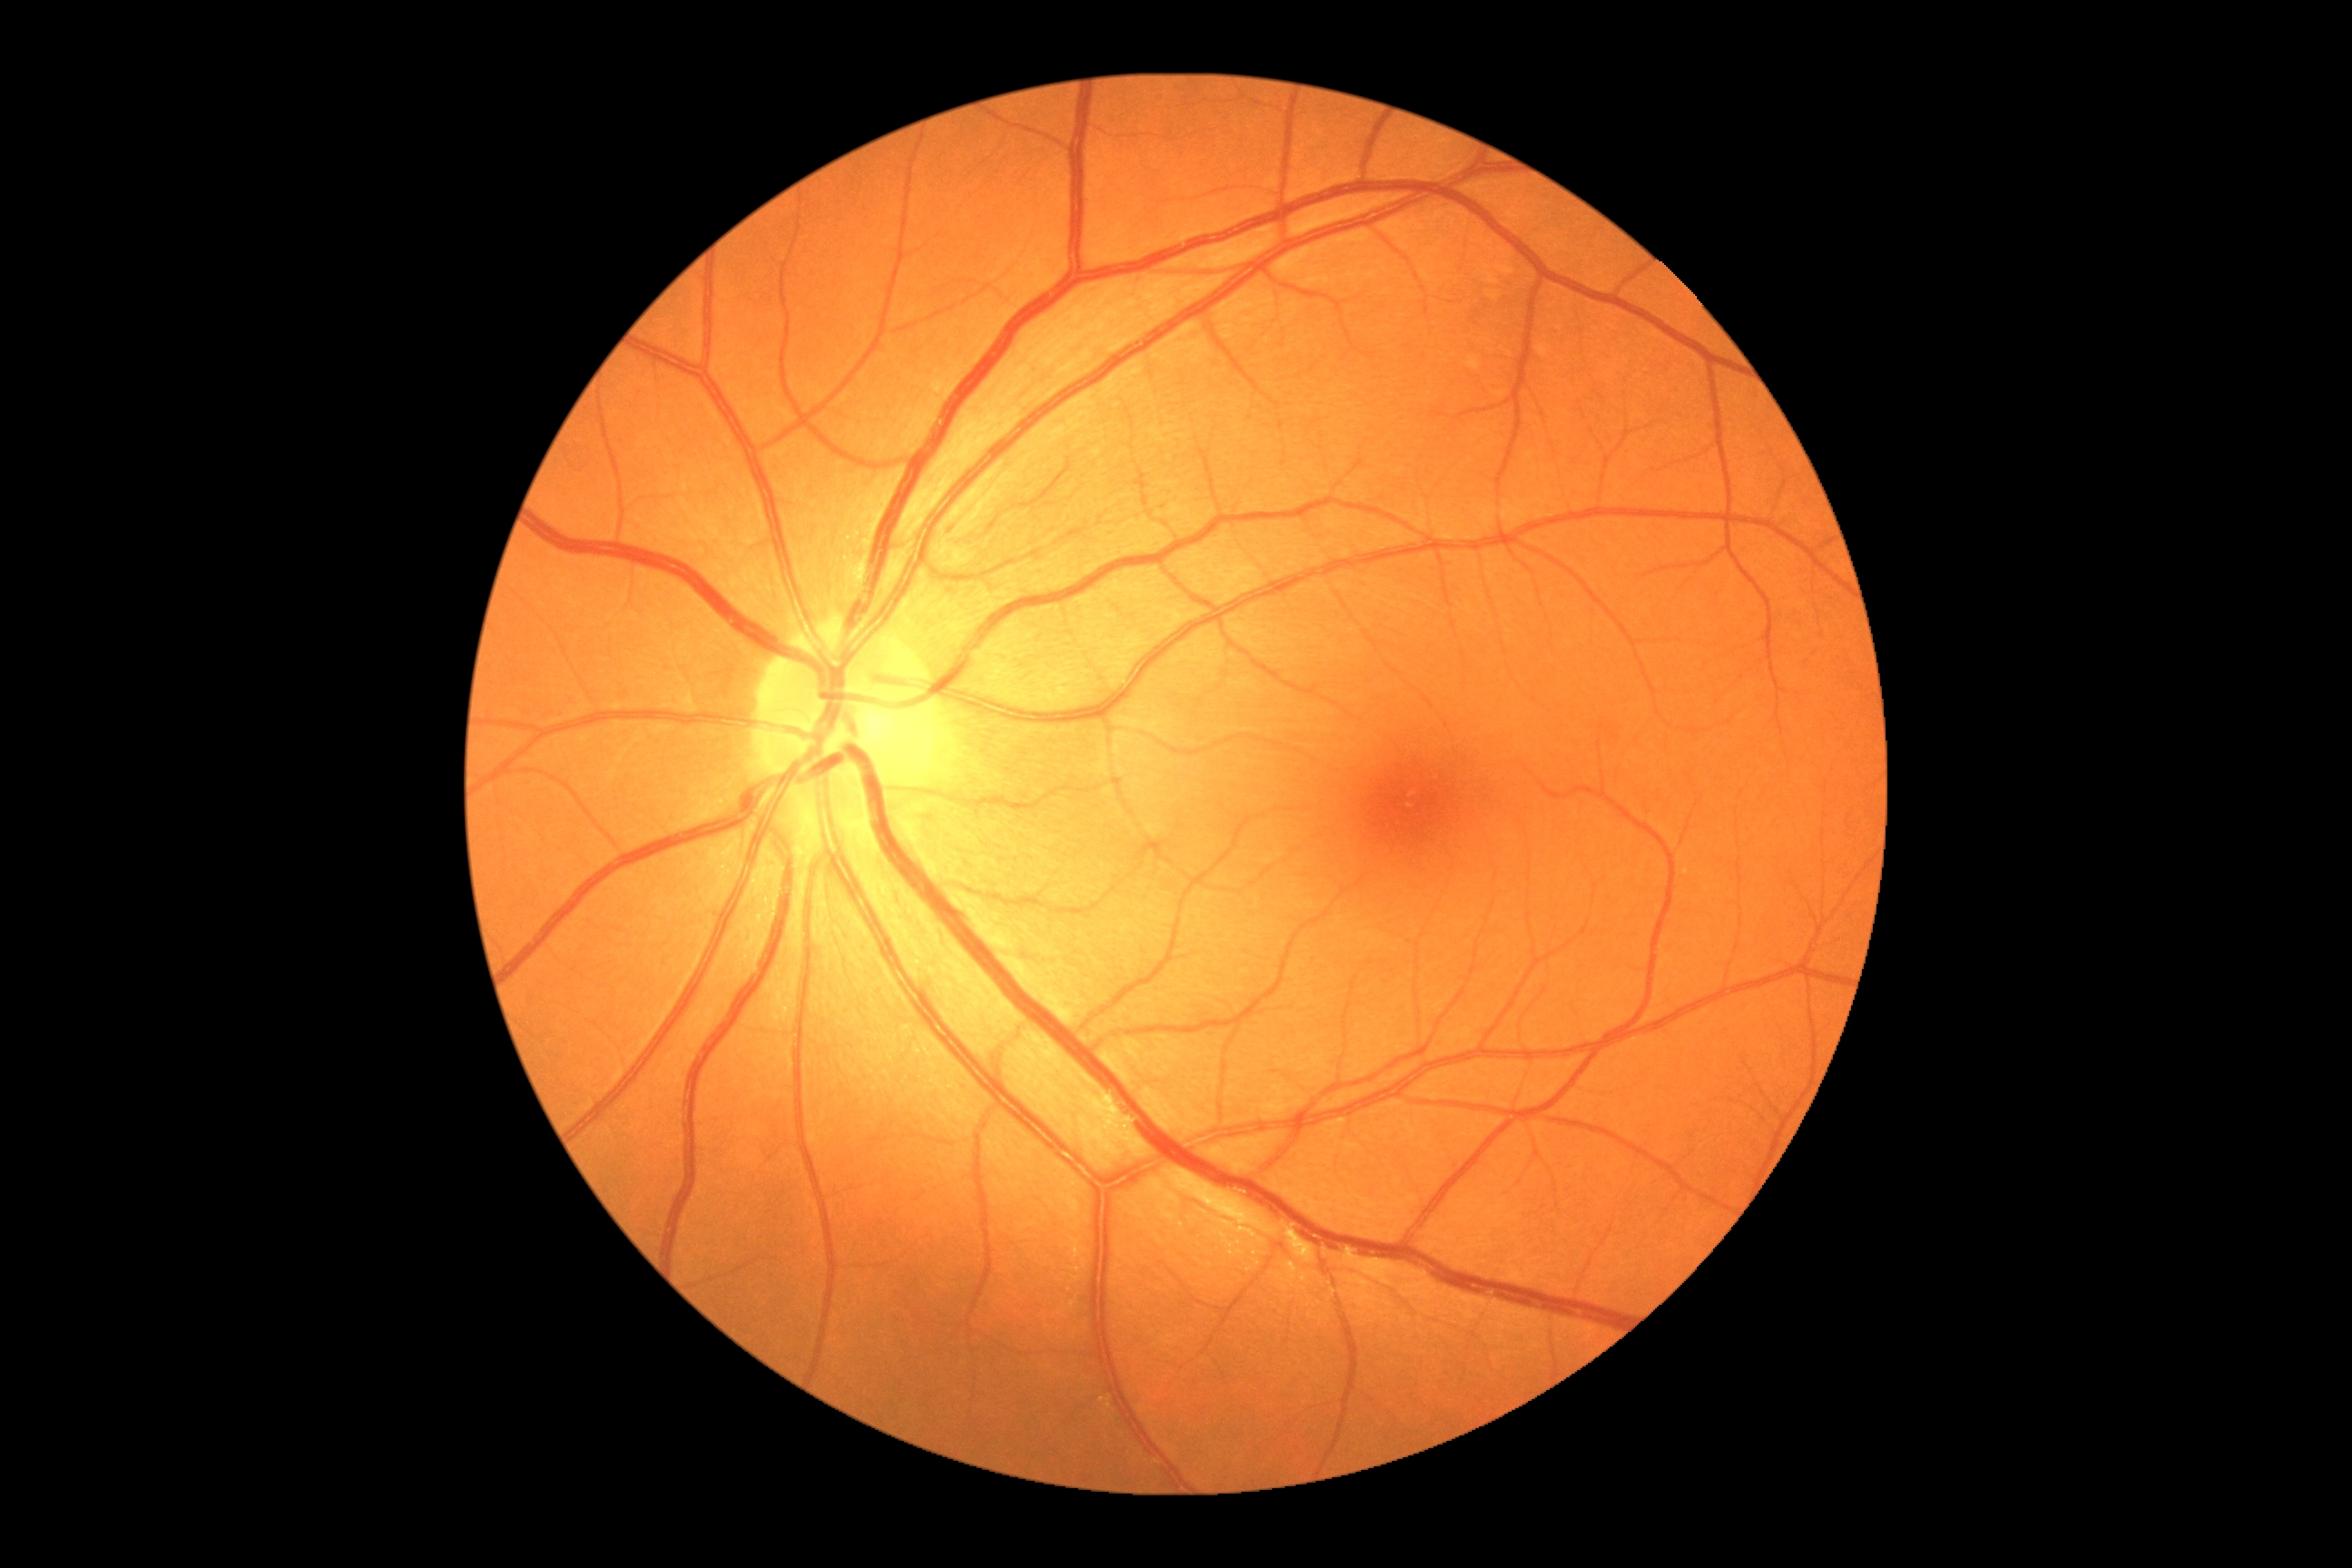 DR stage: 0.